Infant wide-field retinal image.
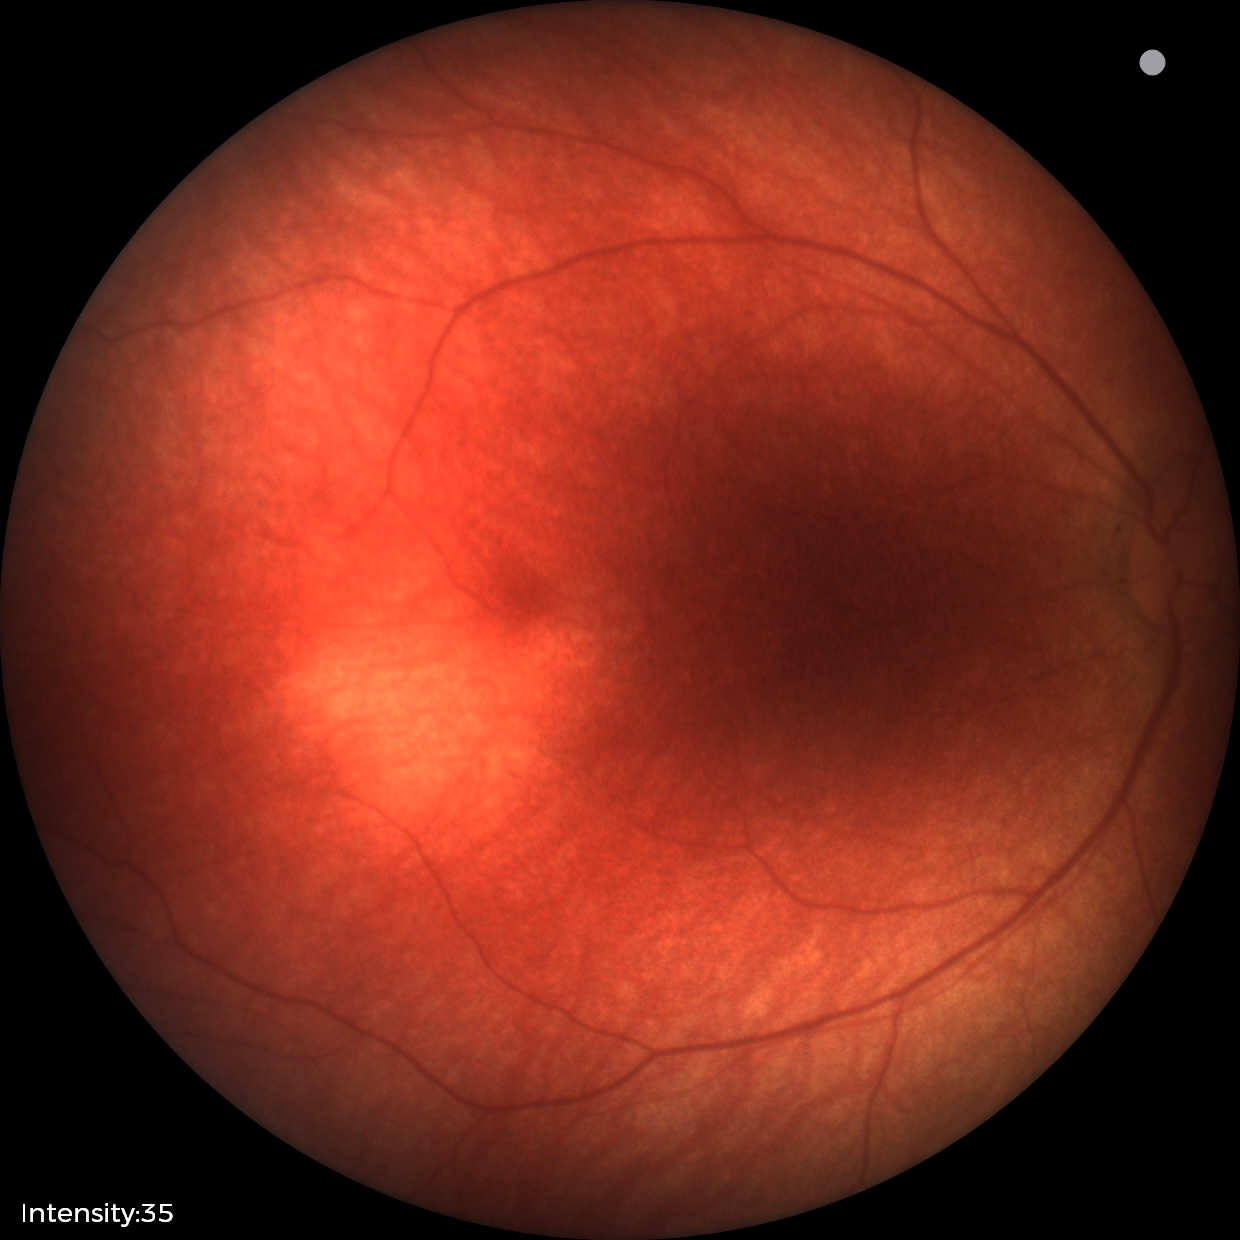
Diagnosis: no pathology identified